FOV: 45 degrees · 2352 x 1568 pixels — 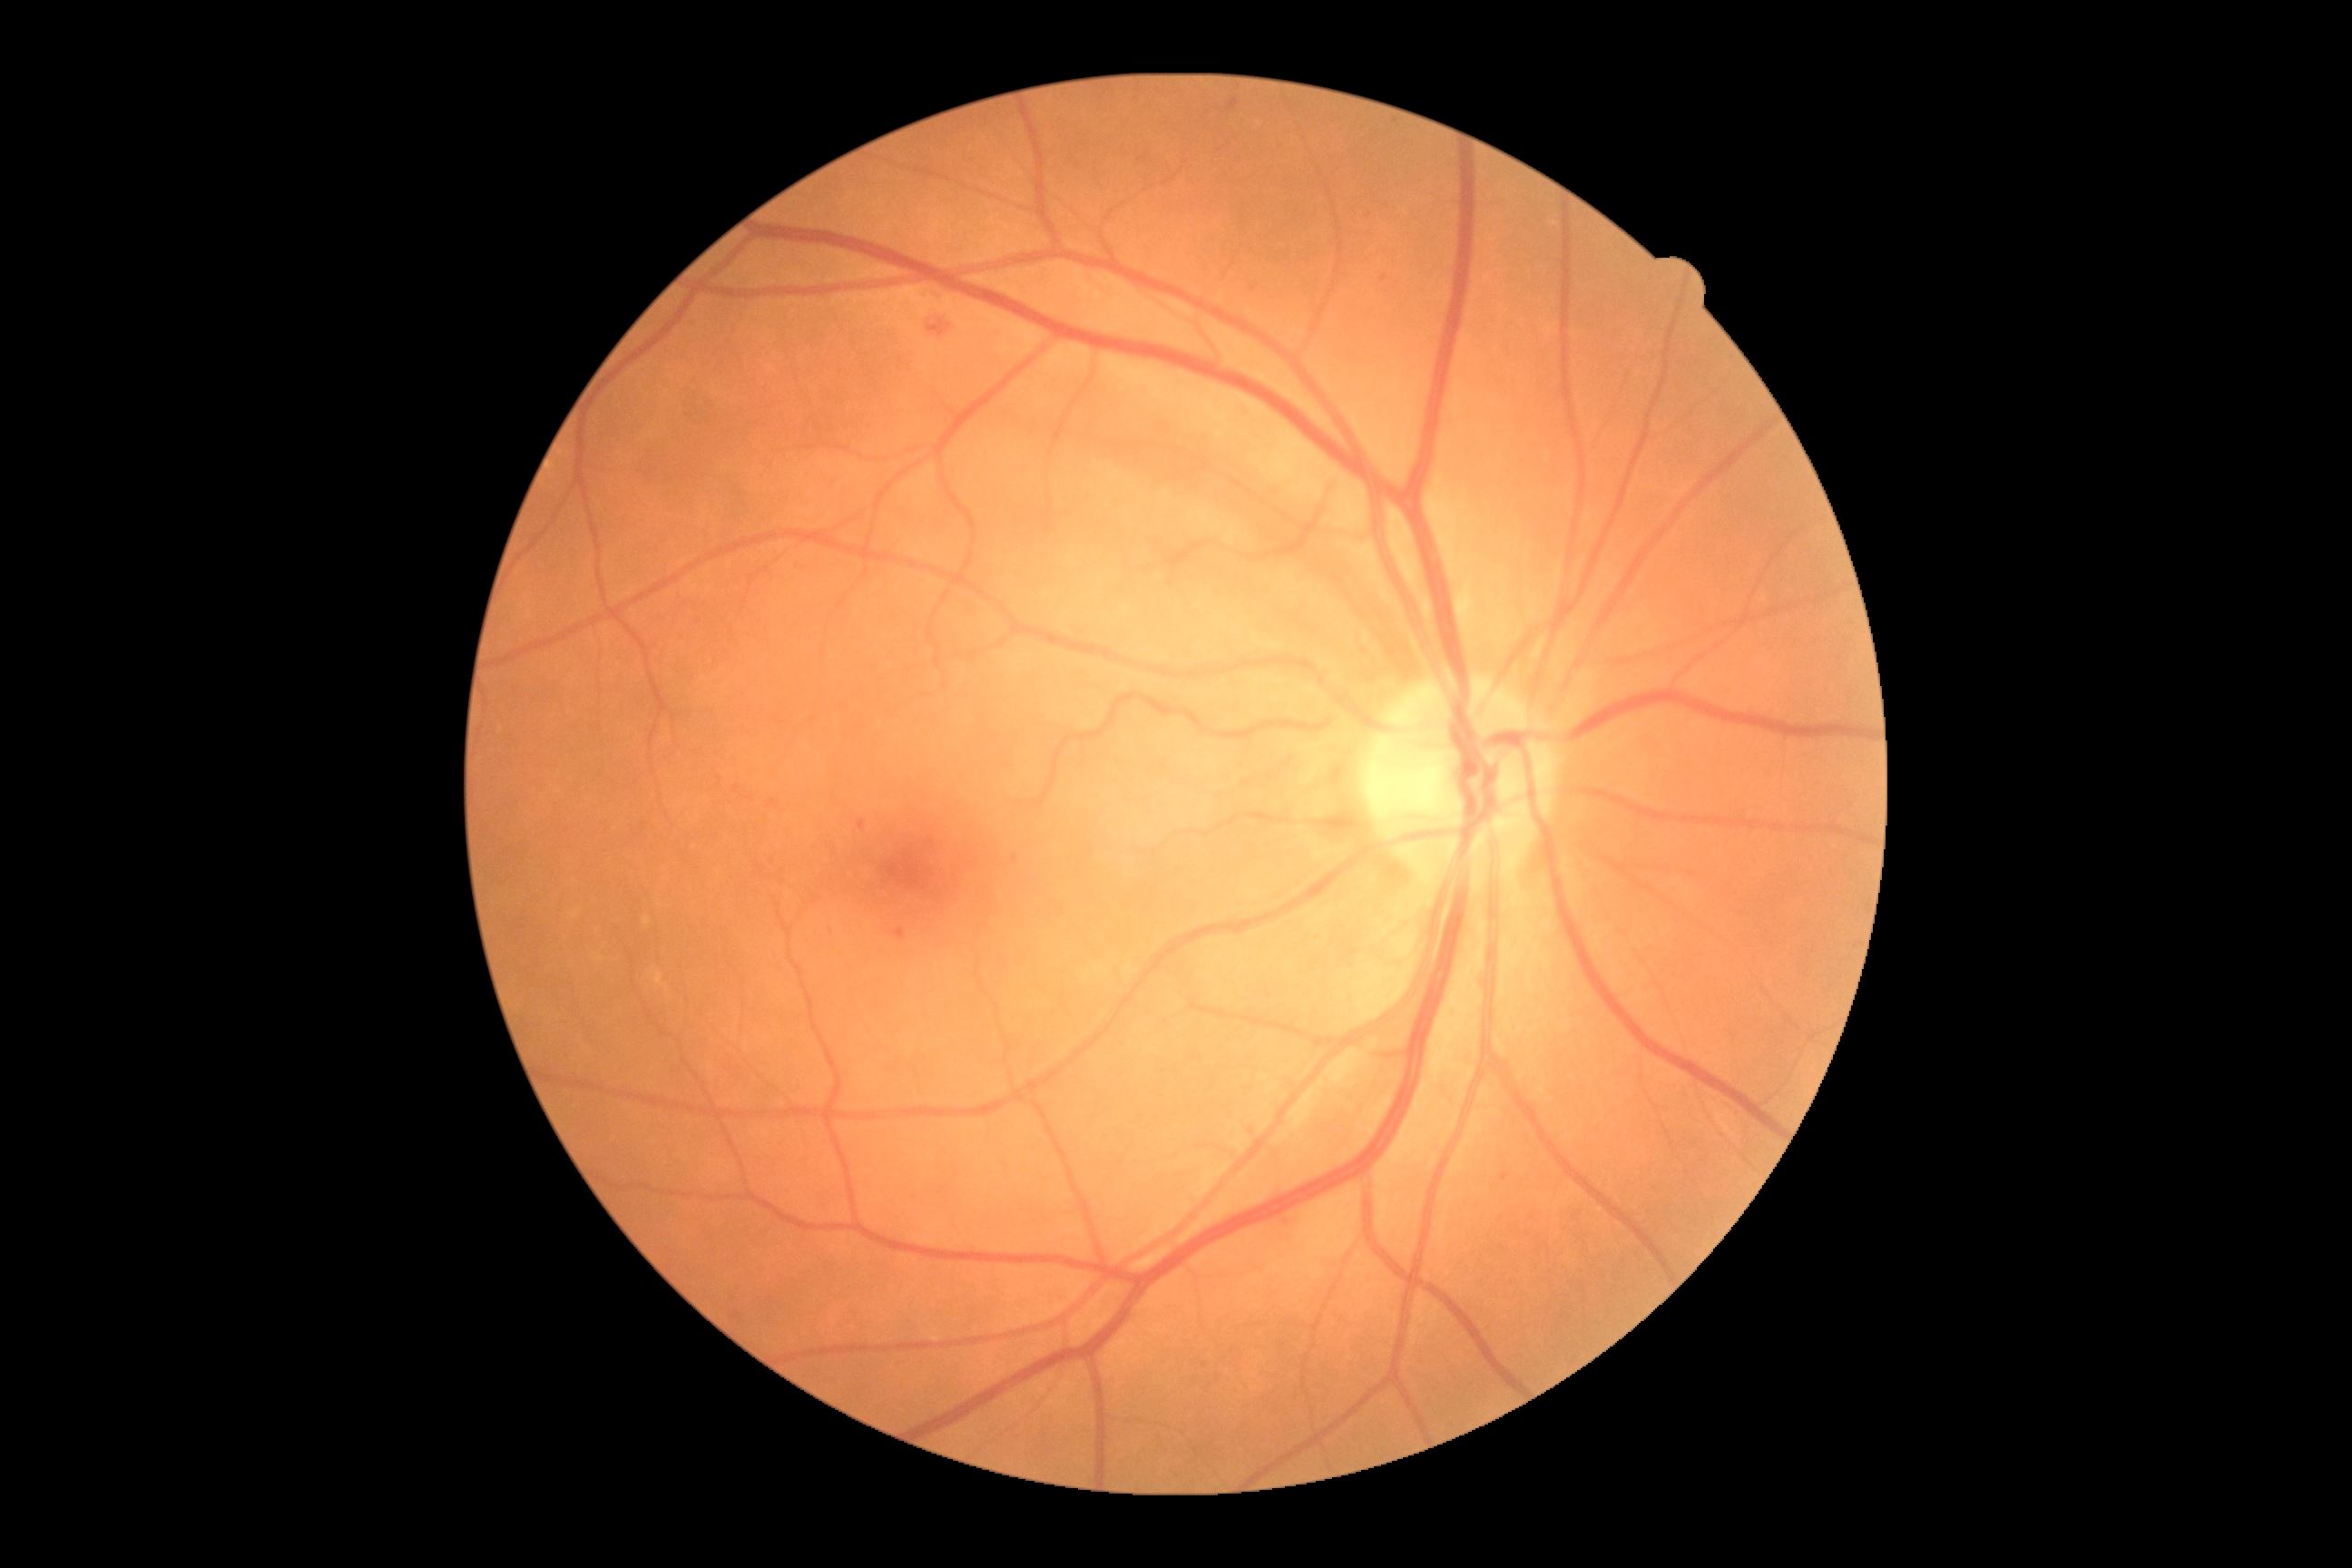
The retinopathy is classified as non-proliferative diabetic retinopathy.
DR stage is 2/4.